Nonmydriatic · camera: NIDEK AFC-230 · graded on the modified Davis scale — 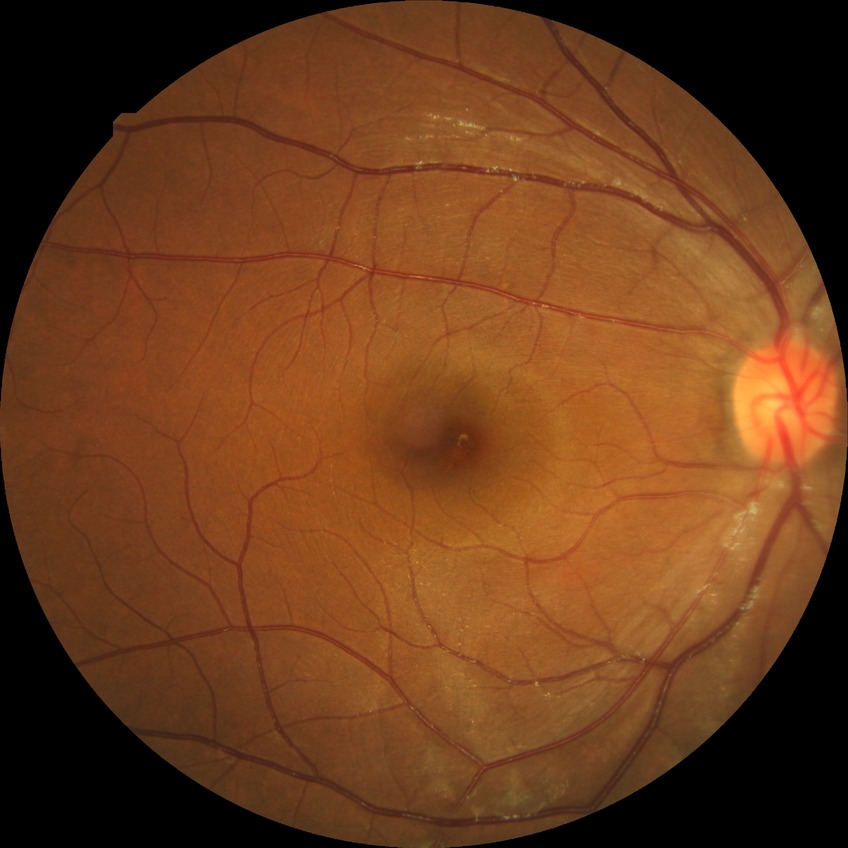

Assessment:
- DR impression: no apparent DR
- Davis grade: NDR